848 by 848 pixels
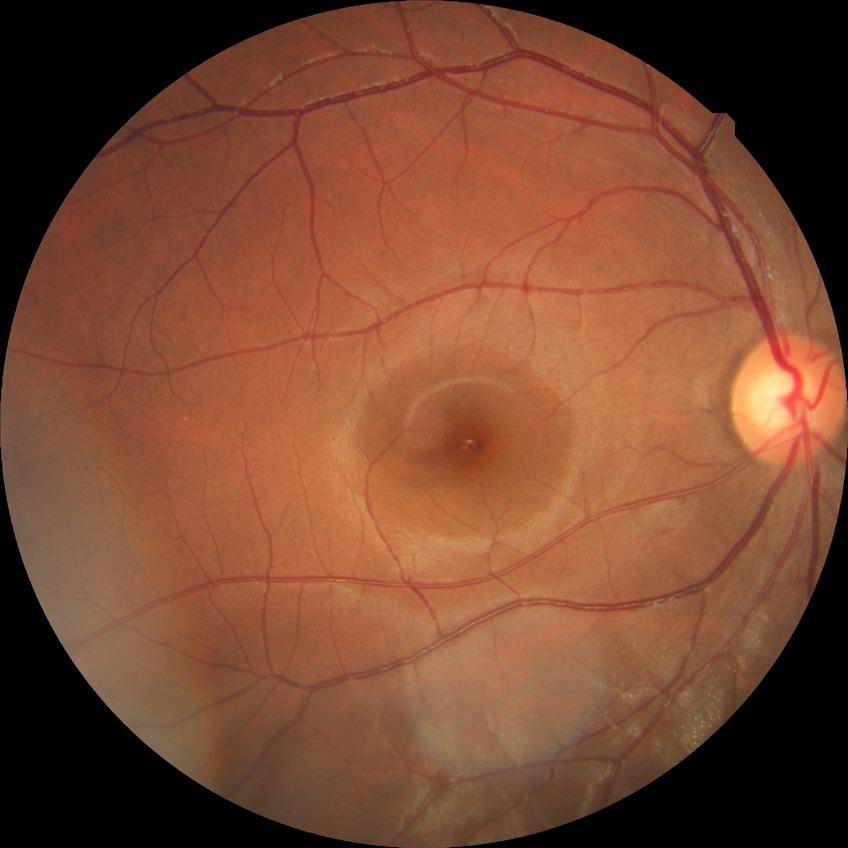 diabetic retinopathy (DR): NDR (no diabetic retinopathy)